Image size 1240x1240. Acquired on the Phoenix ICON. Wide-field fundus photograph from neonatal ROP screening.
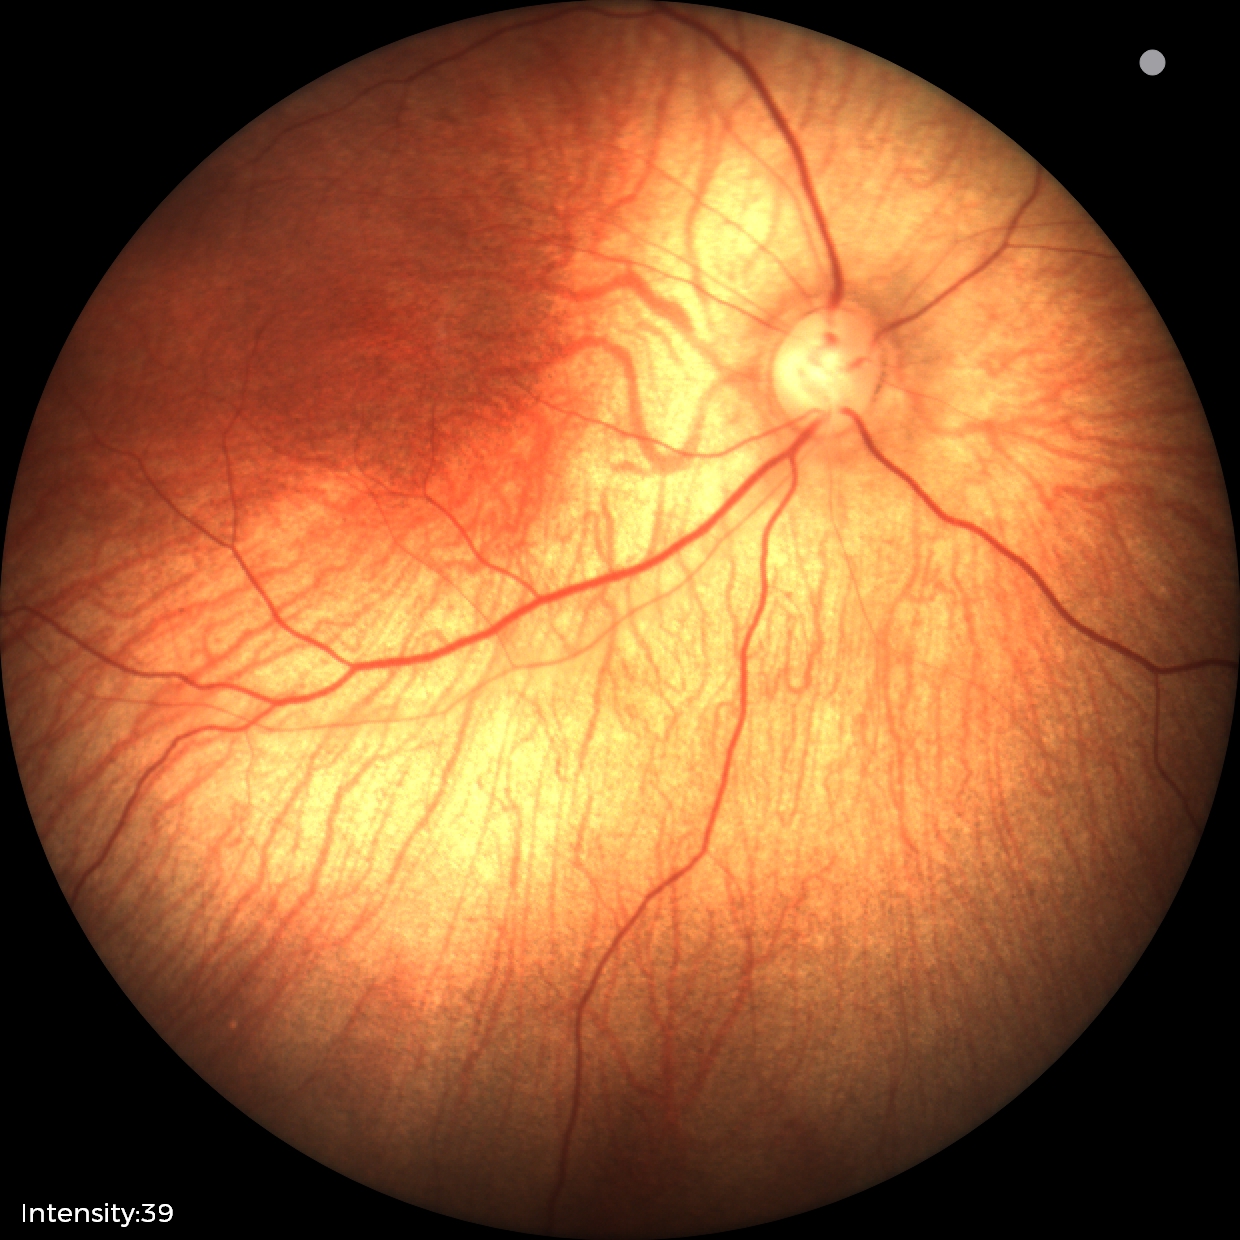 Assessment: physiological appearance with no retinal pathology.